Infant wide-field retinal image; 640x480
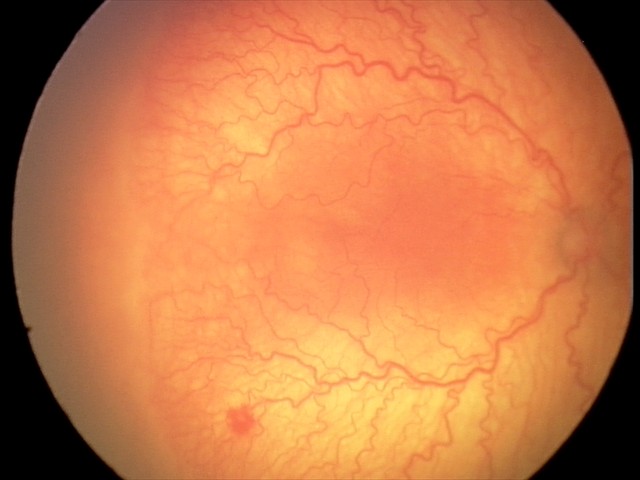
Q: What was the screening finding?
A: aggressive retinopathy of prematurity (A-ROP) — rapidly progressive severe ROP with prominent plus disease, often without classic stage progression
Q: What is the plus-form classification?
A: plus disease